NIDEK AFC-230: 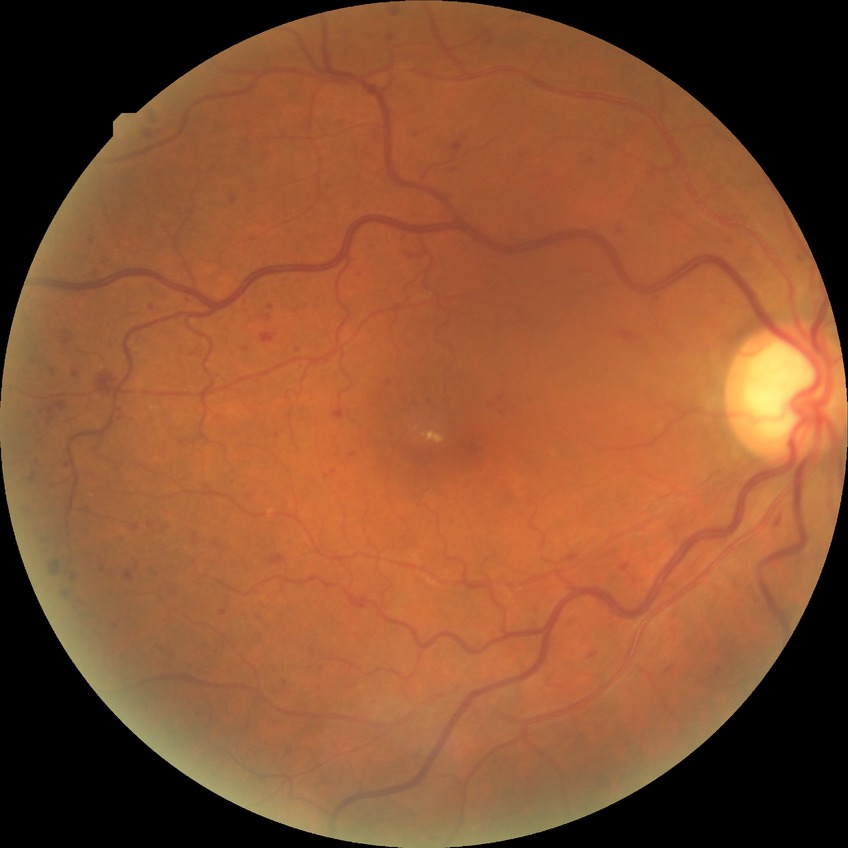

Retinopathy stage: no diabetic retinopathy.